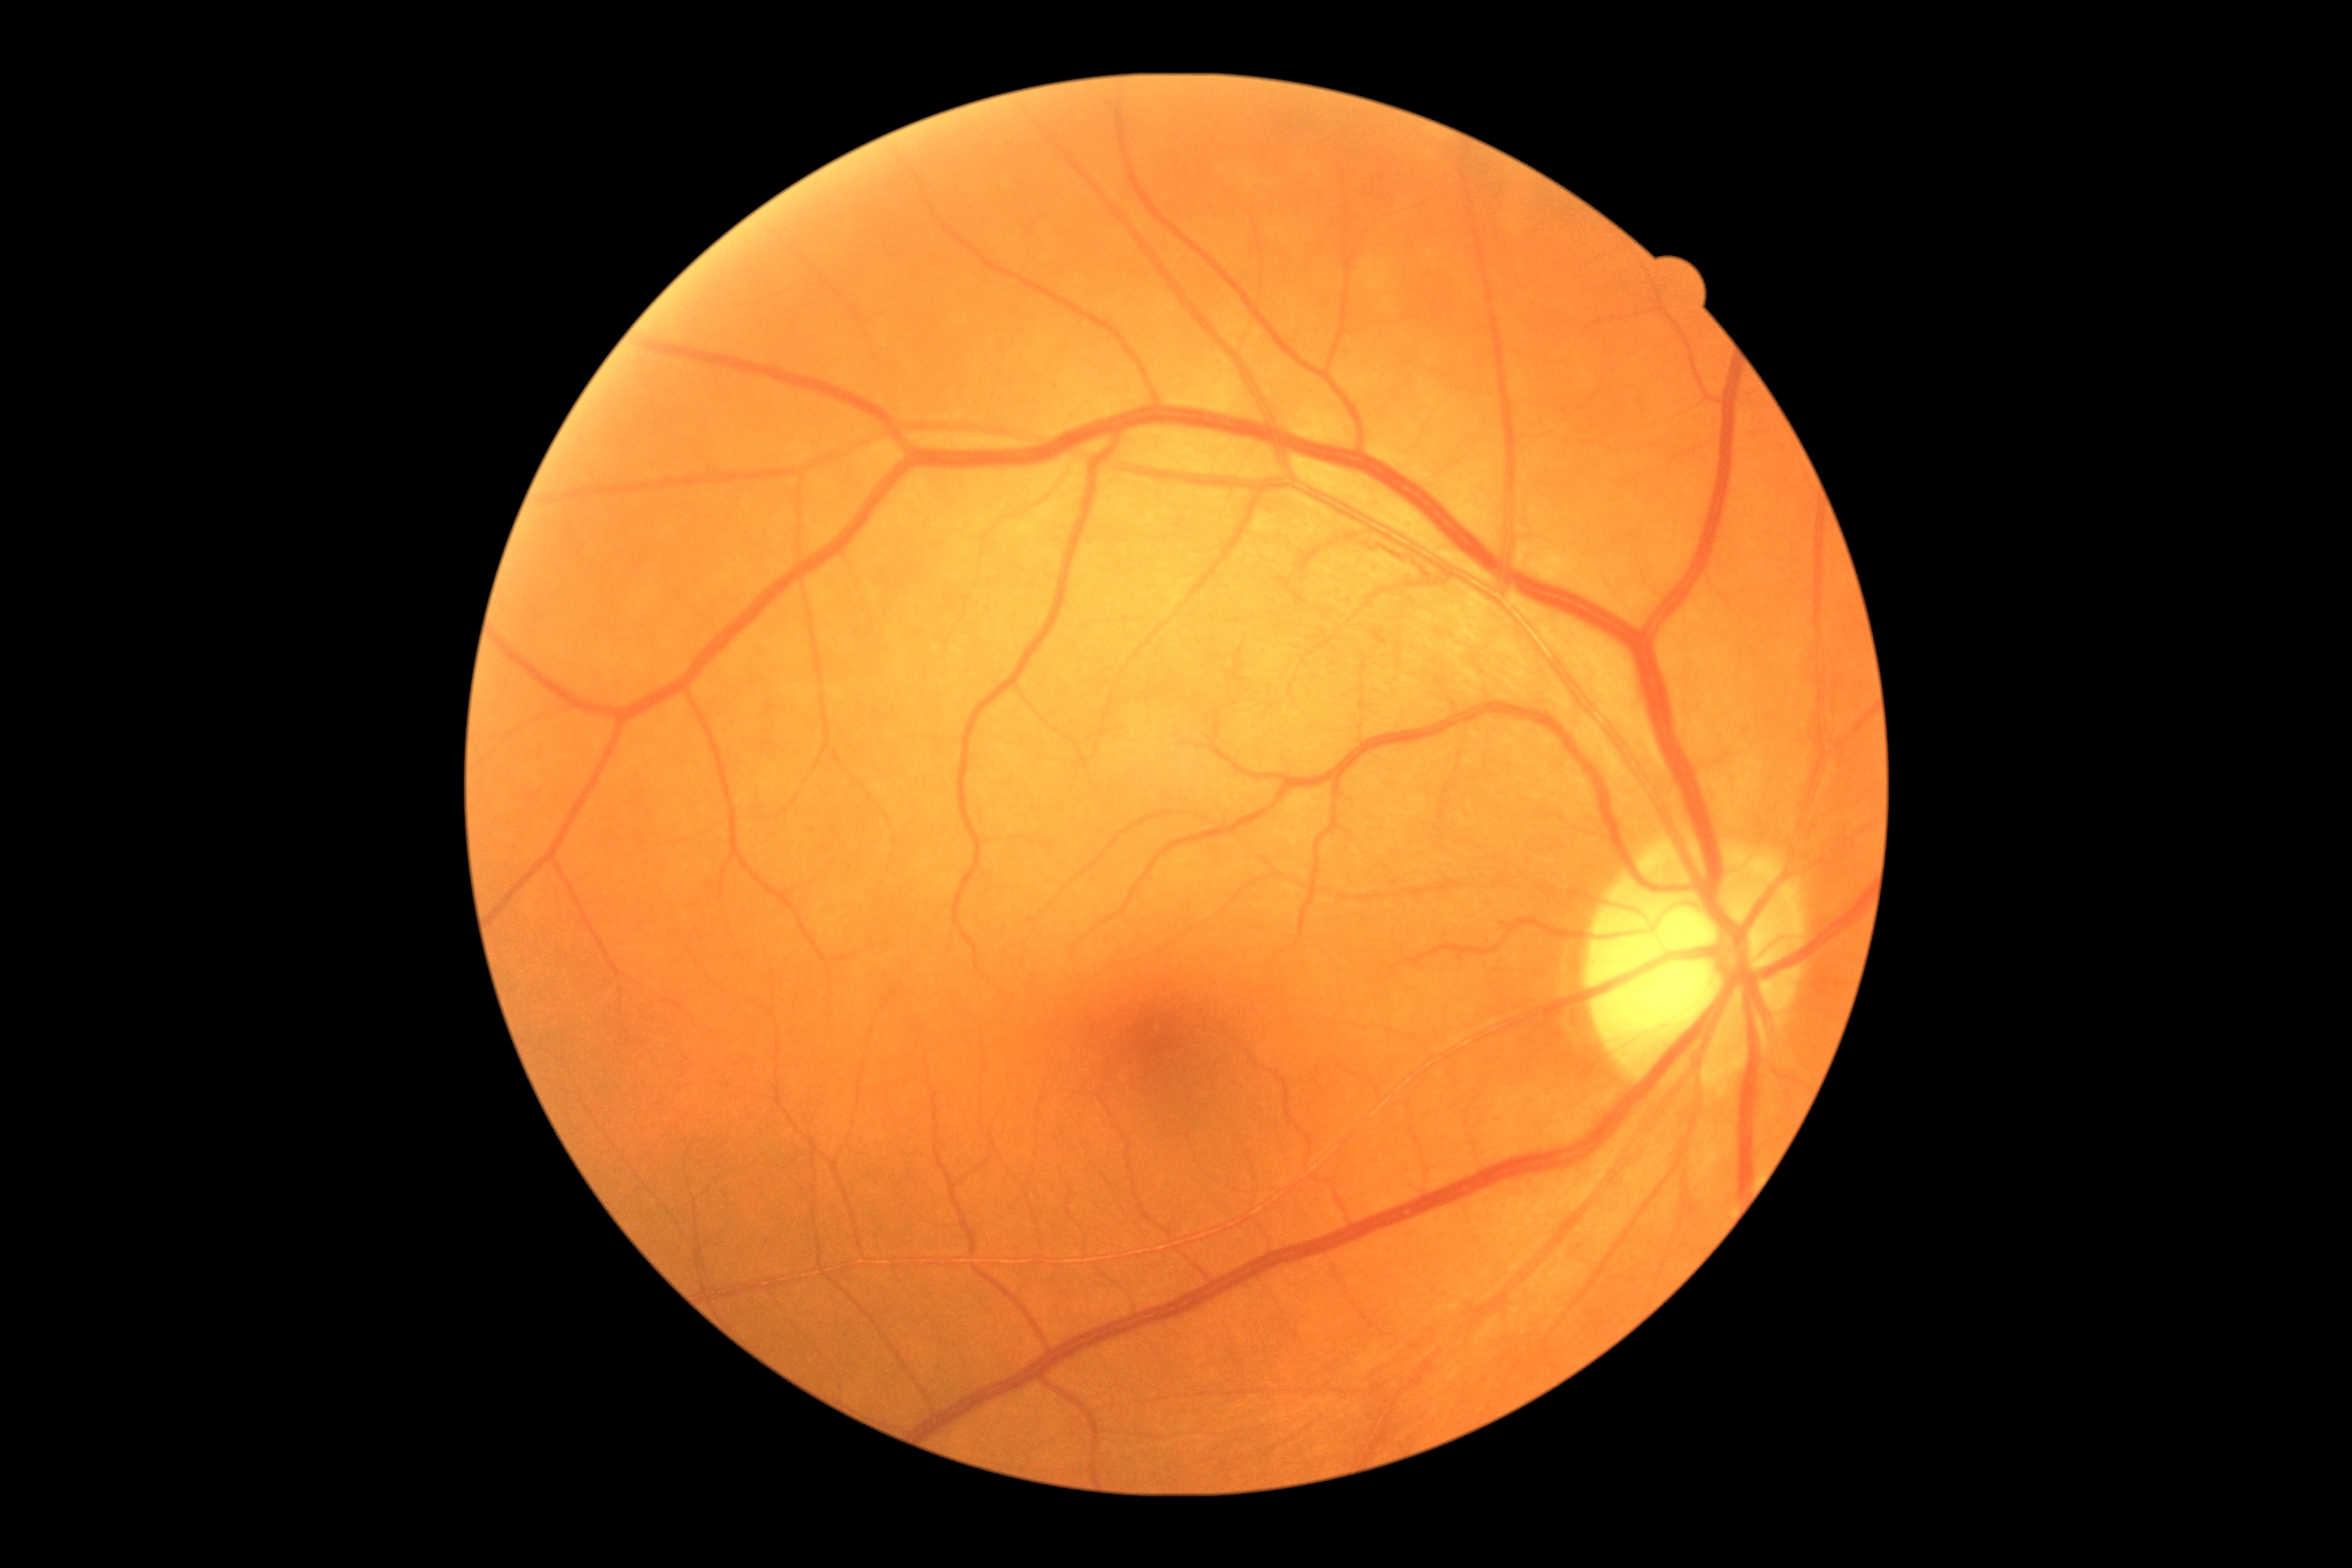
Diabetic retinopathy (DR) is grade 0.